Color fundus image.
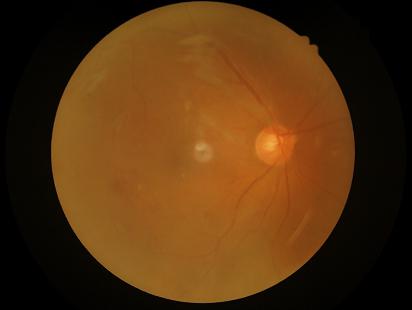
Illumination = no over- or under-exposure | Contrast = good dynamic range | Focus = reduced sharpness with visible blur | Overall quality = inadequate for clinical interpretation.